CFP · 50-degree field of view · captured on a Topcon TRC-50DX fundus camera · central posterior field: 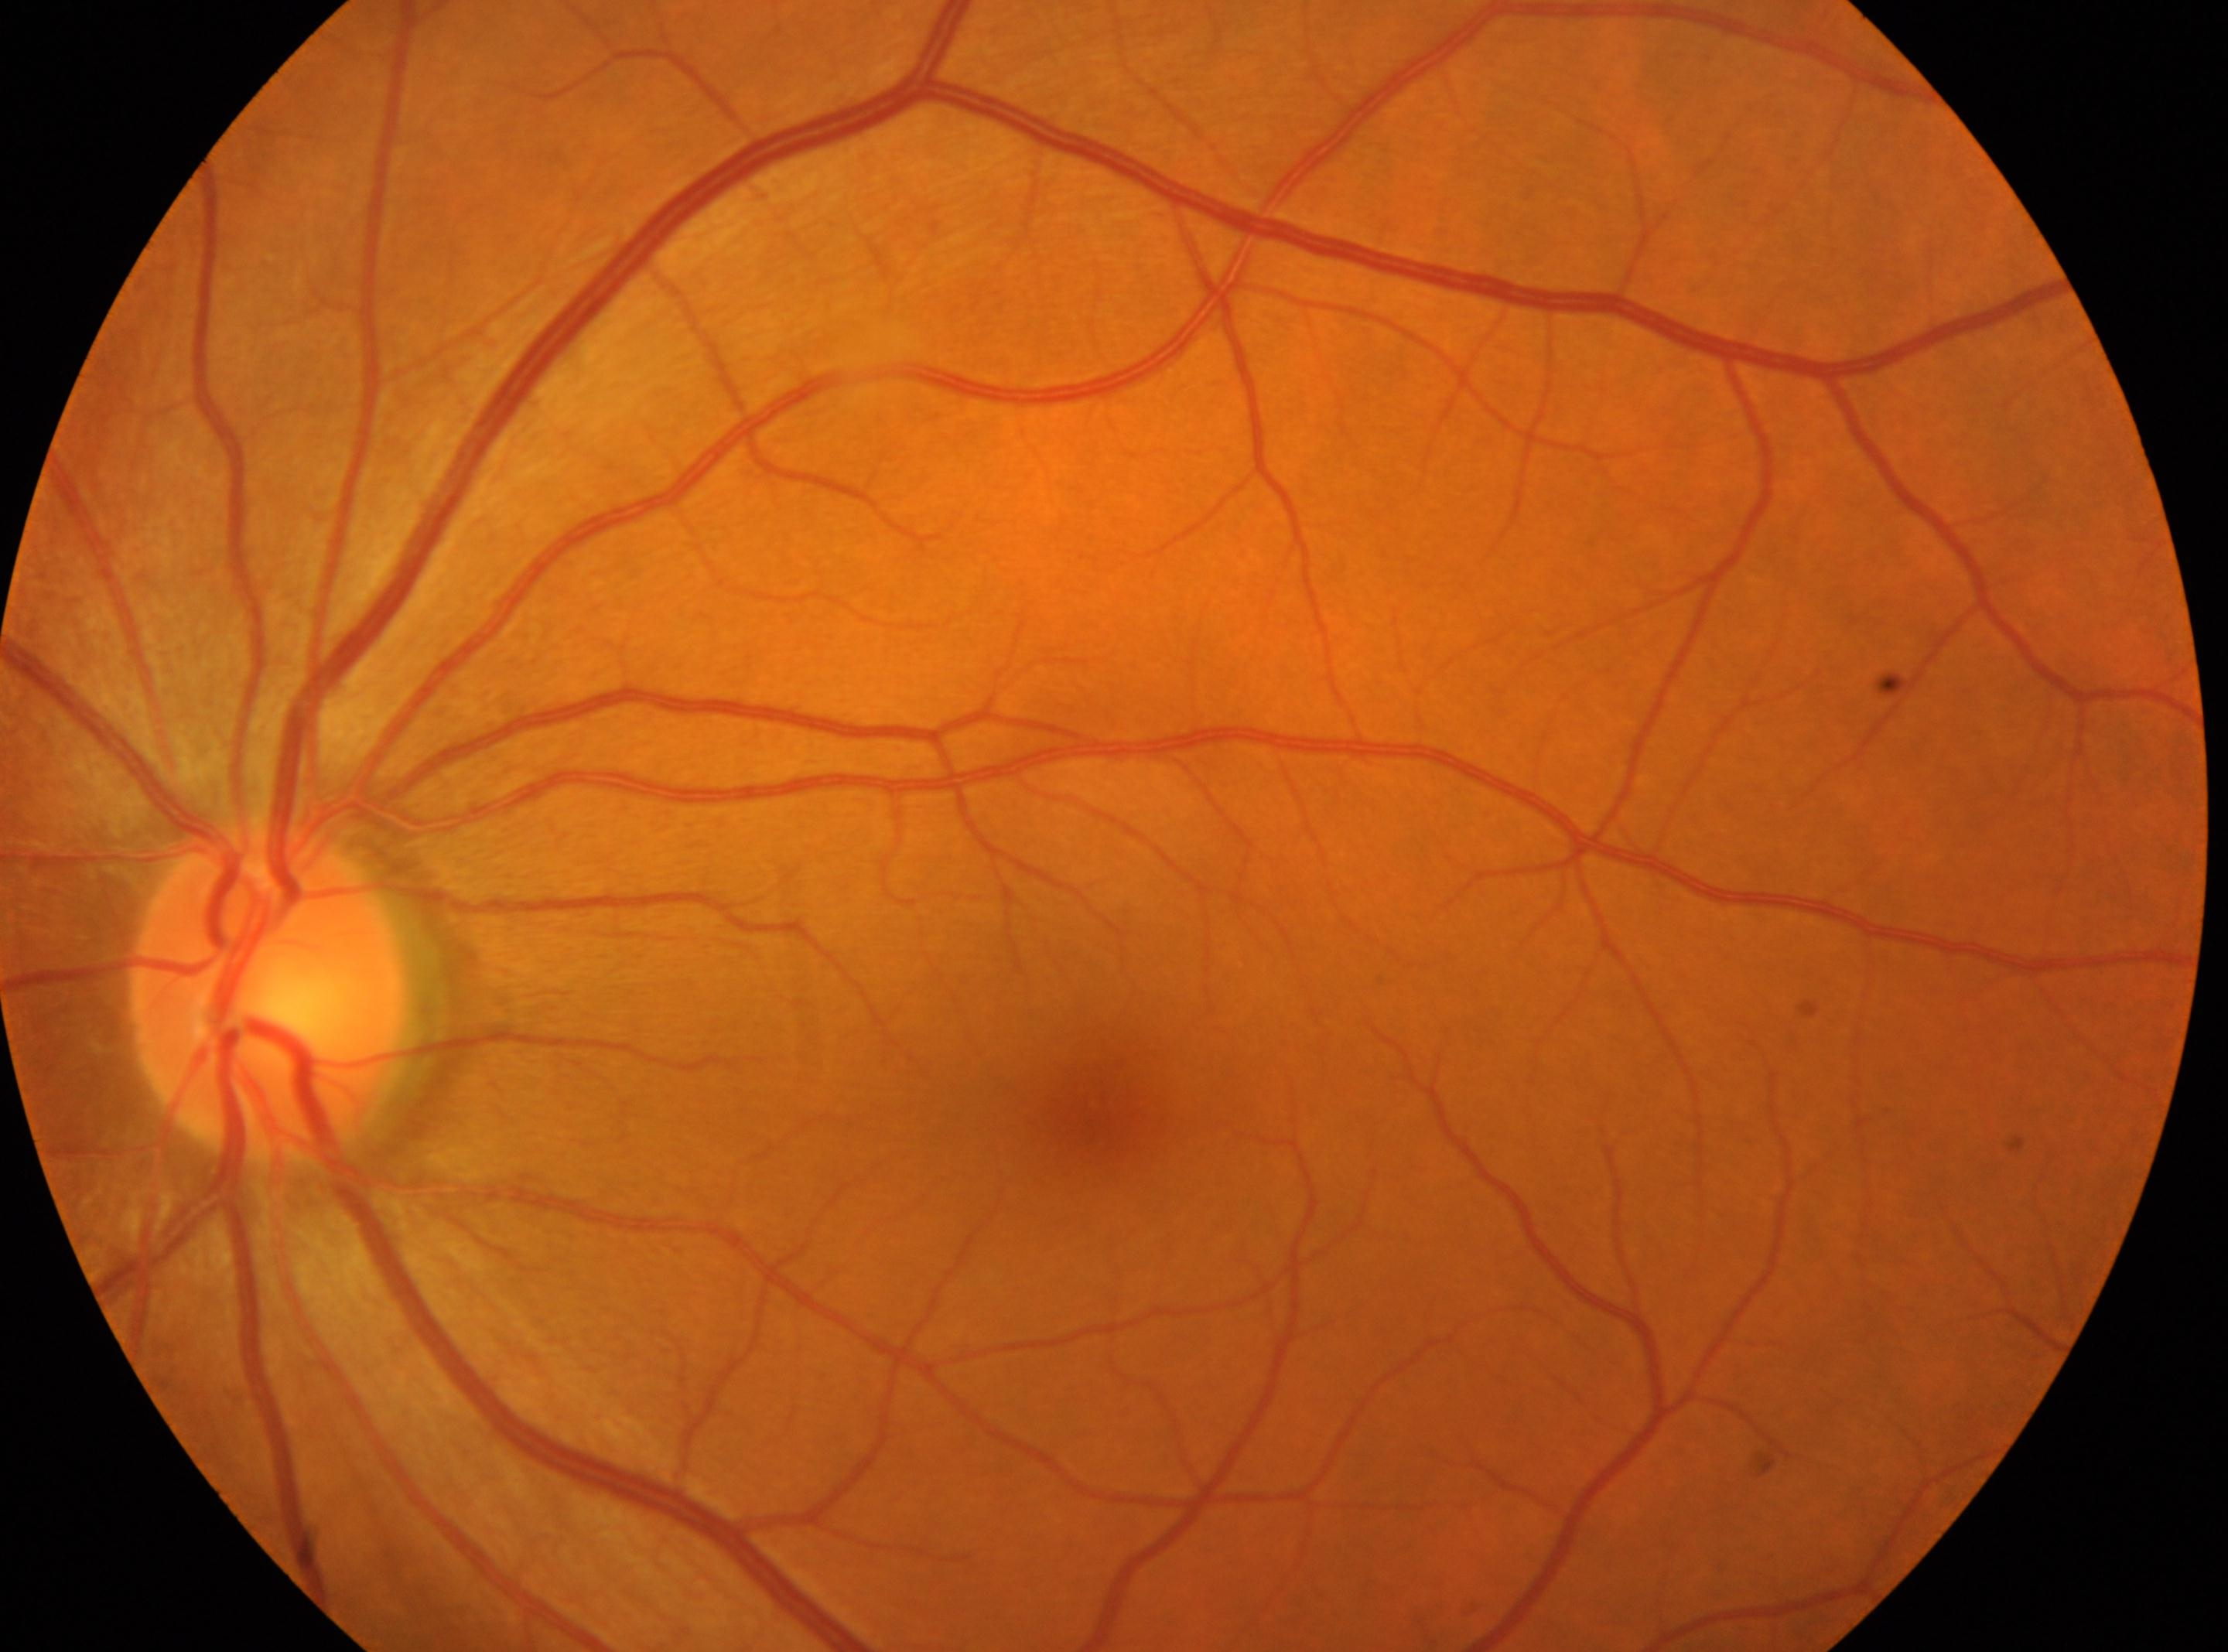
Disc center: 269px, 991px.
The image shows the oculus sinister.
Retinopathy is 0/4 — no visible signs of diabetic retinopathy.
Fovea located at 1102px, 1098px.